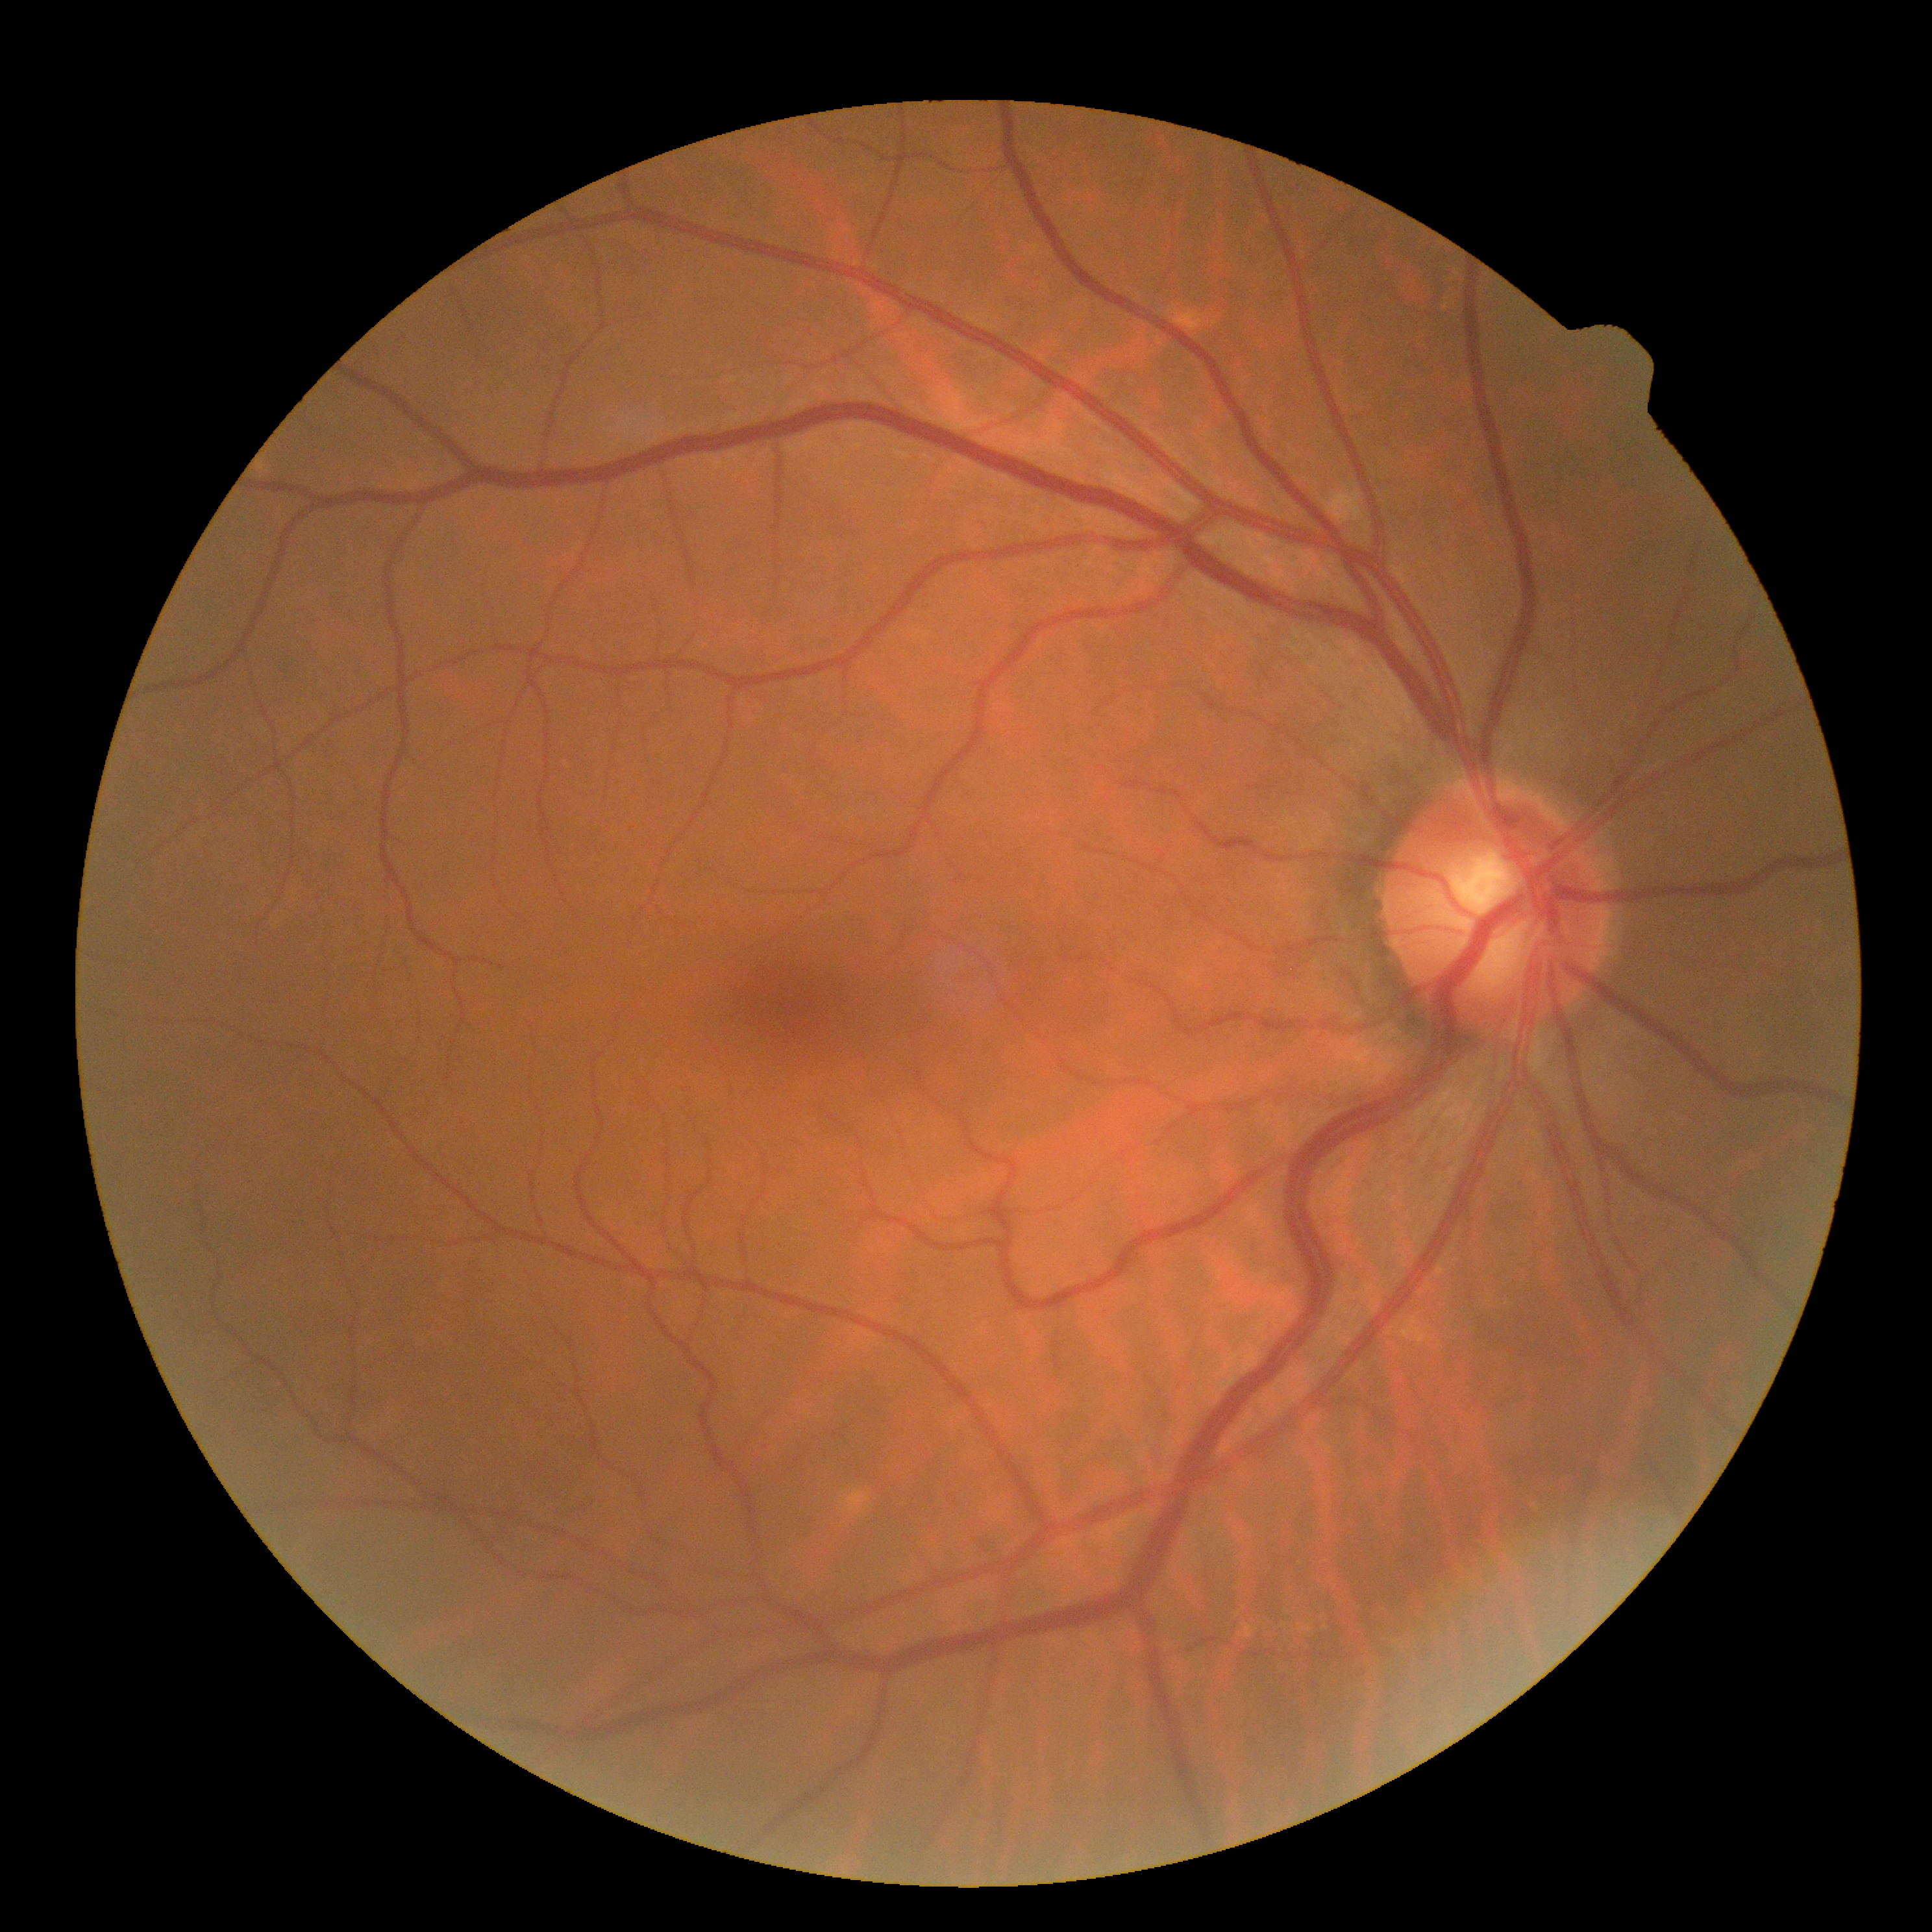 {"dr_impression": "negative for DR", "dr_grade": "no apparent retinopathy (grade 0) — no visible signs of diabetic retinopathy"}